2048 by 1536 pixels; CFP
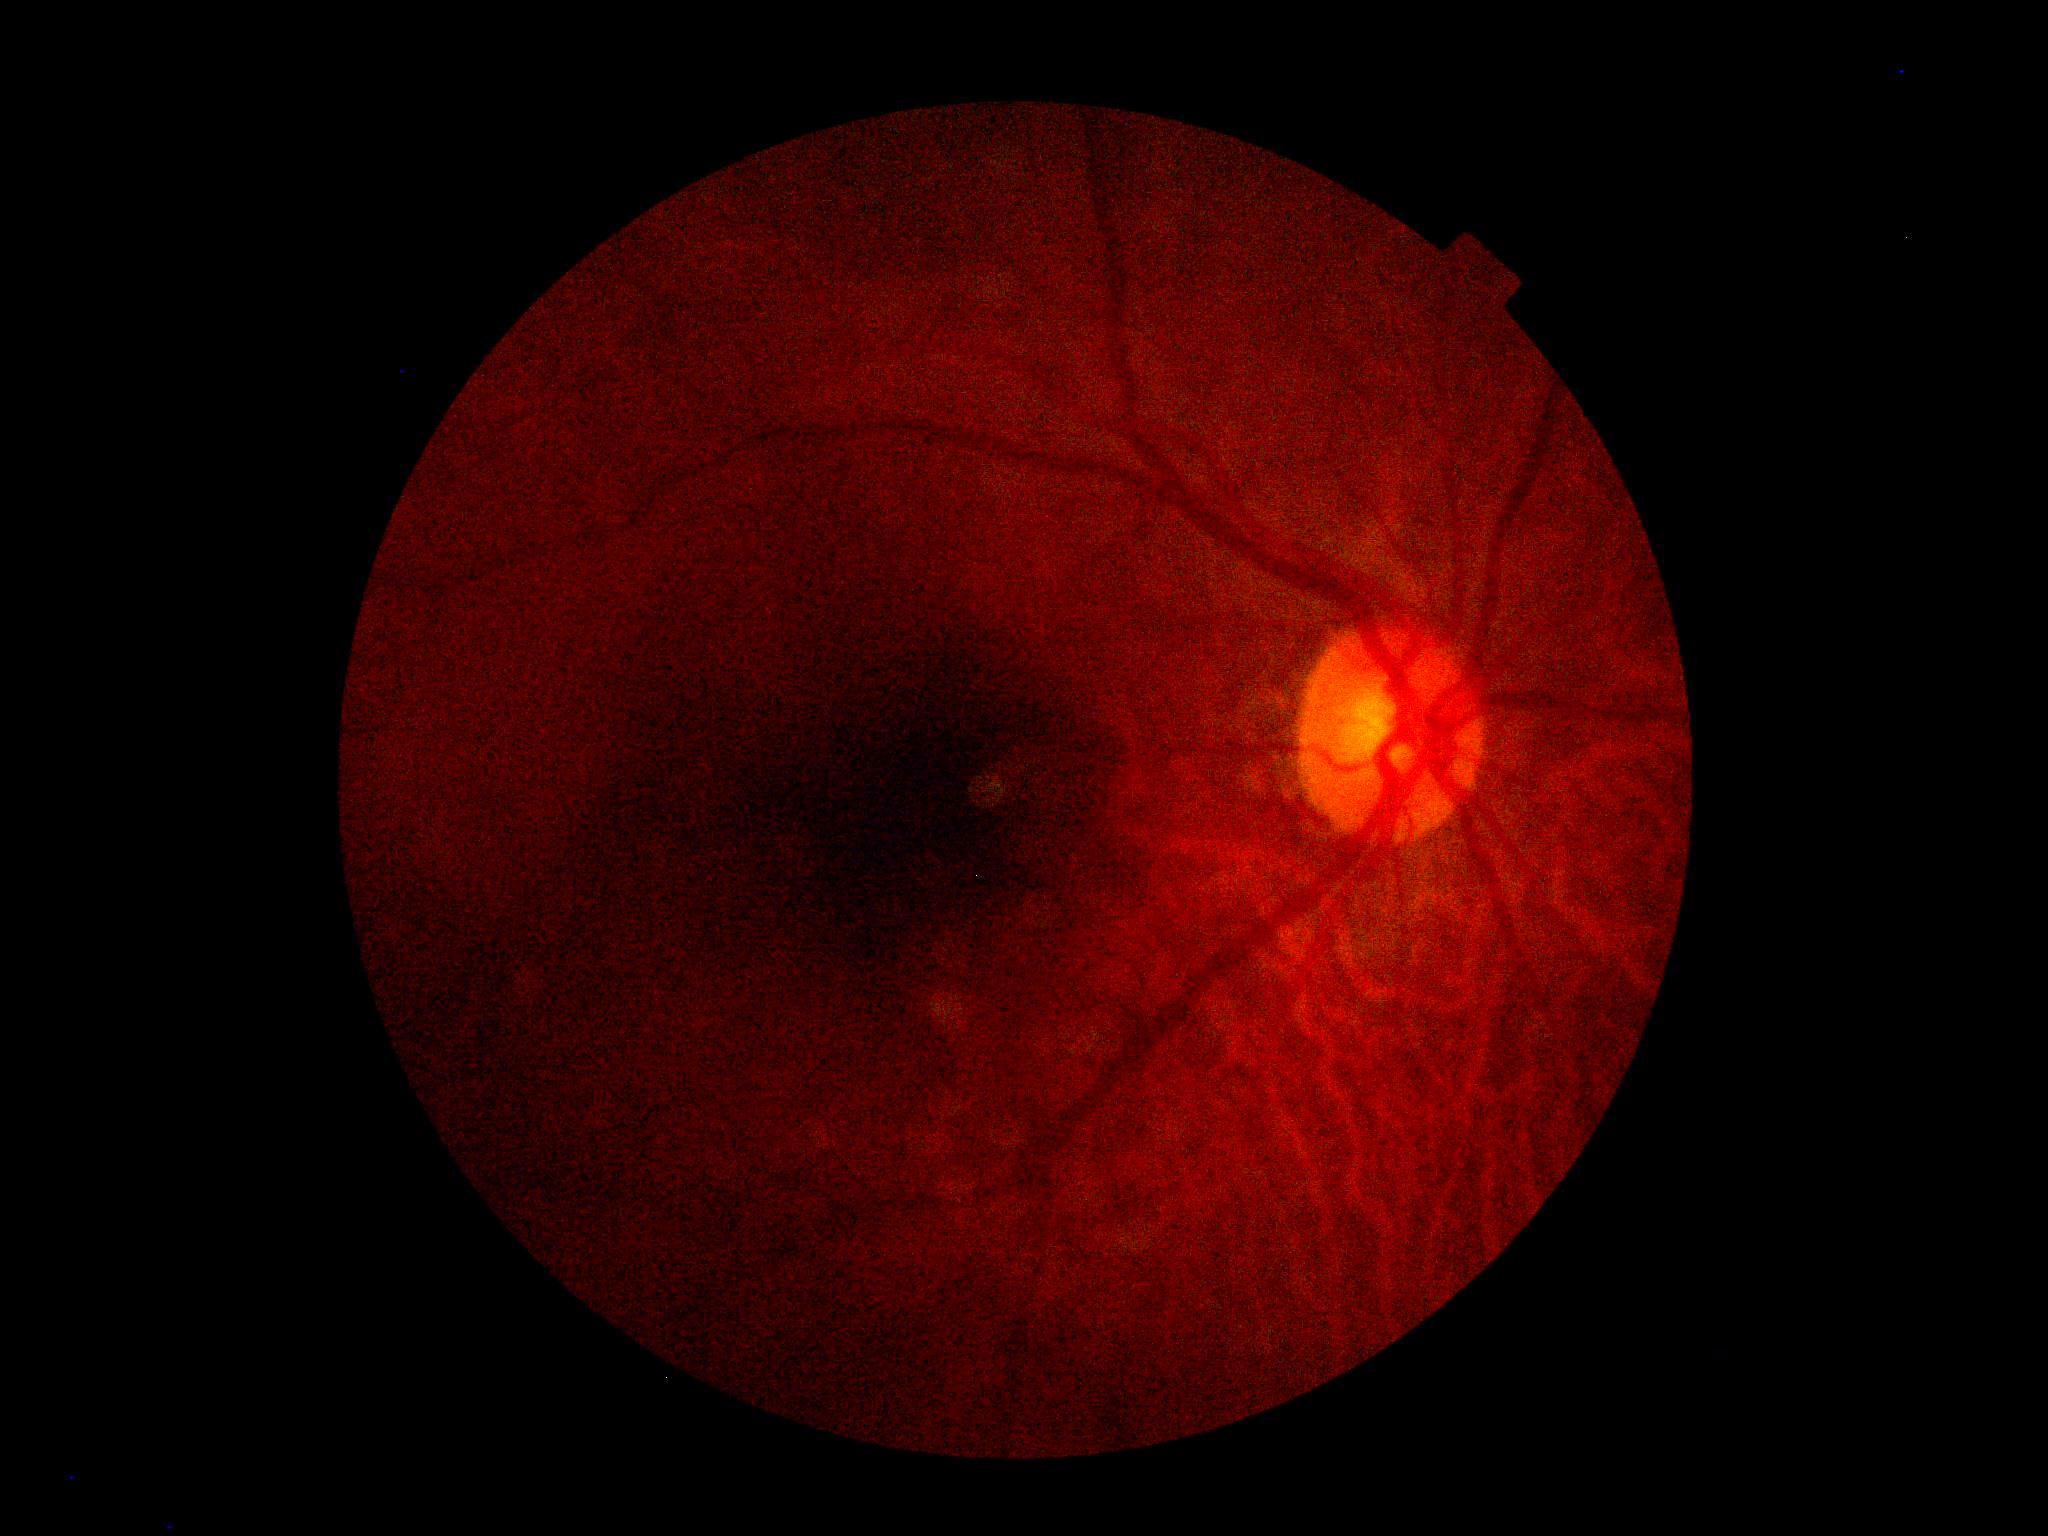

Ungradable image — DR severity cannot be determined.
DR grade is ungradable due to poor image quality.